848x848px — 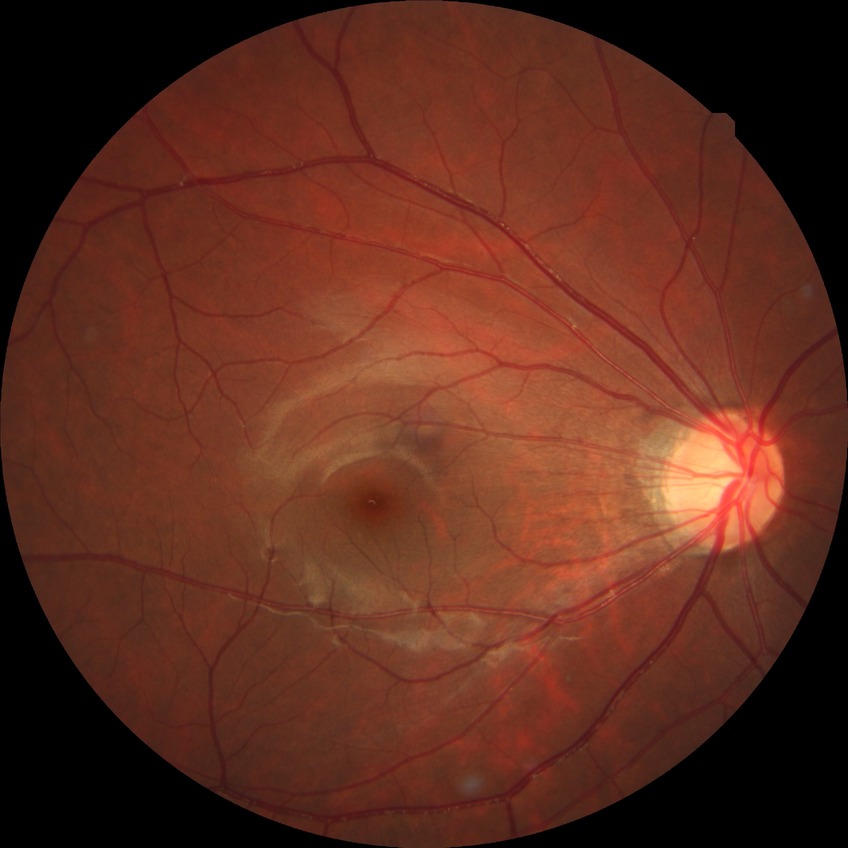 diabetic retinopathy (DR) = NDR (no diabetic retinopathy).